2212 x 1659 pixels.
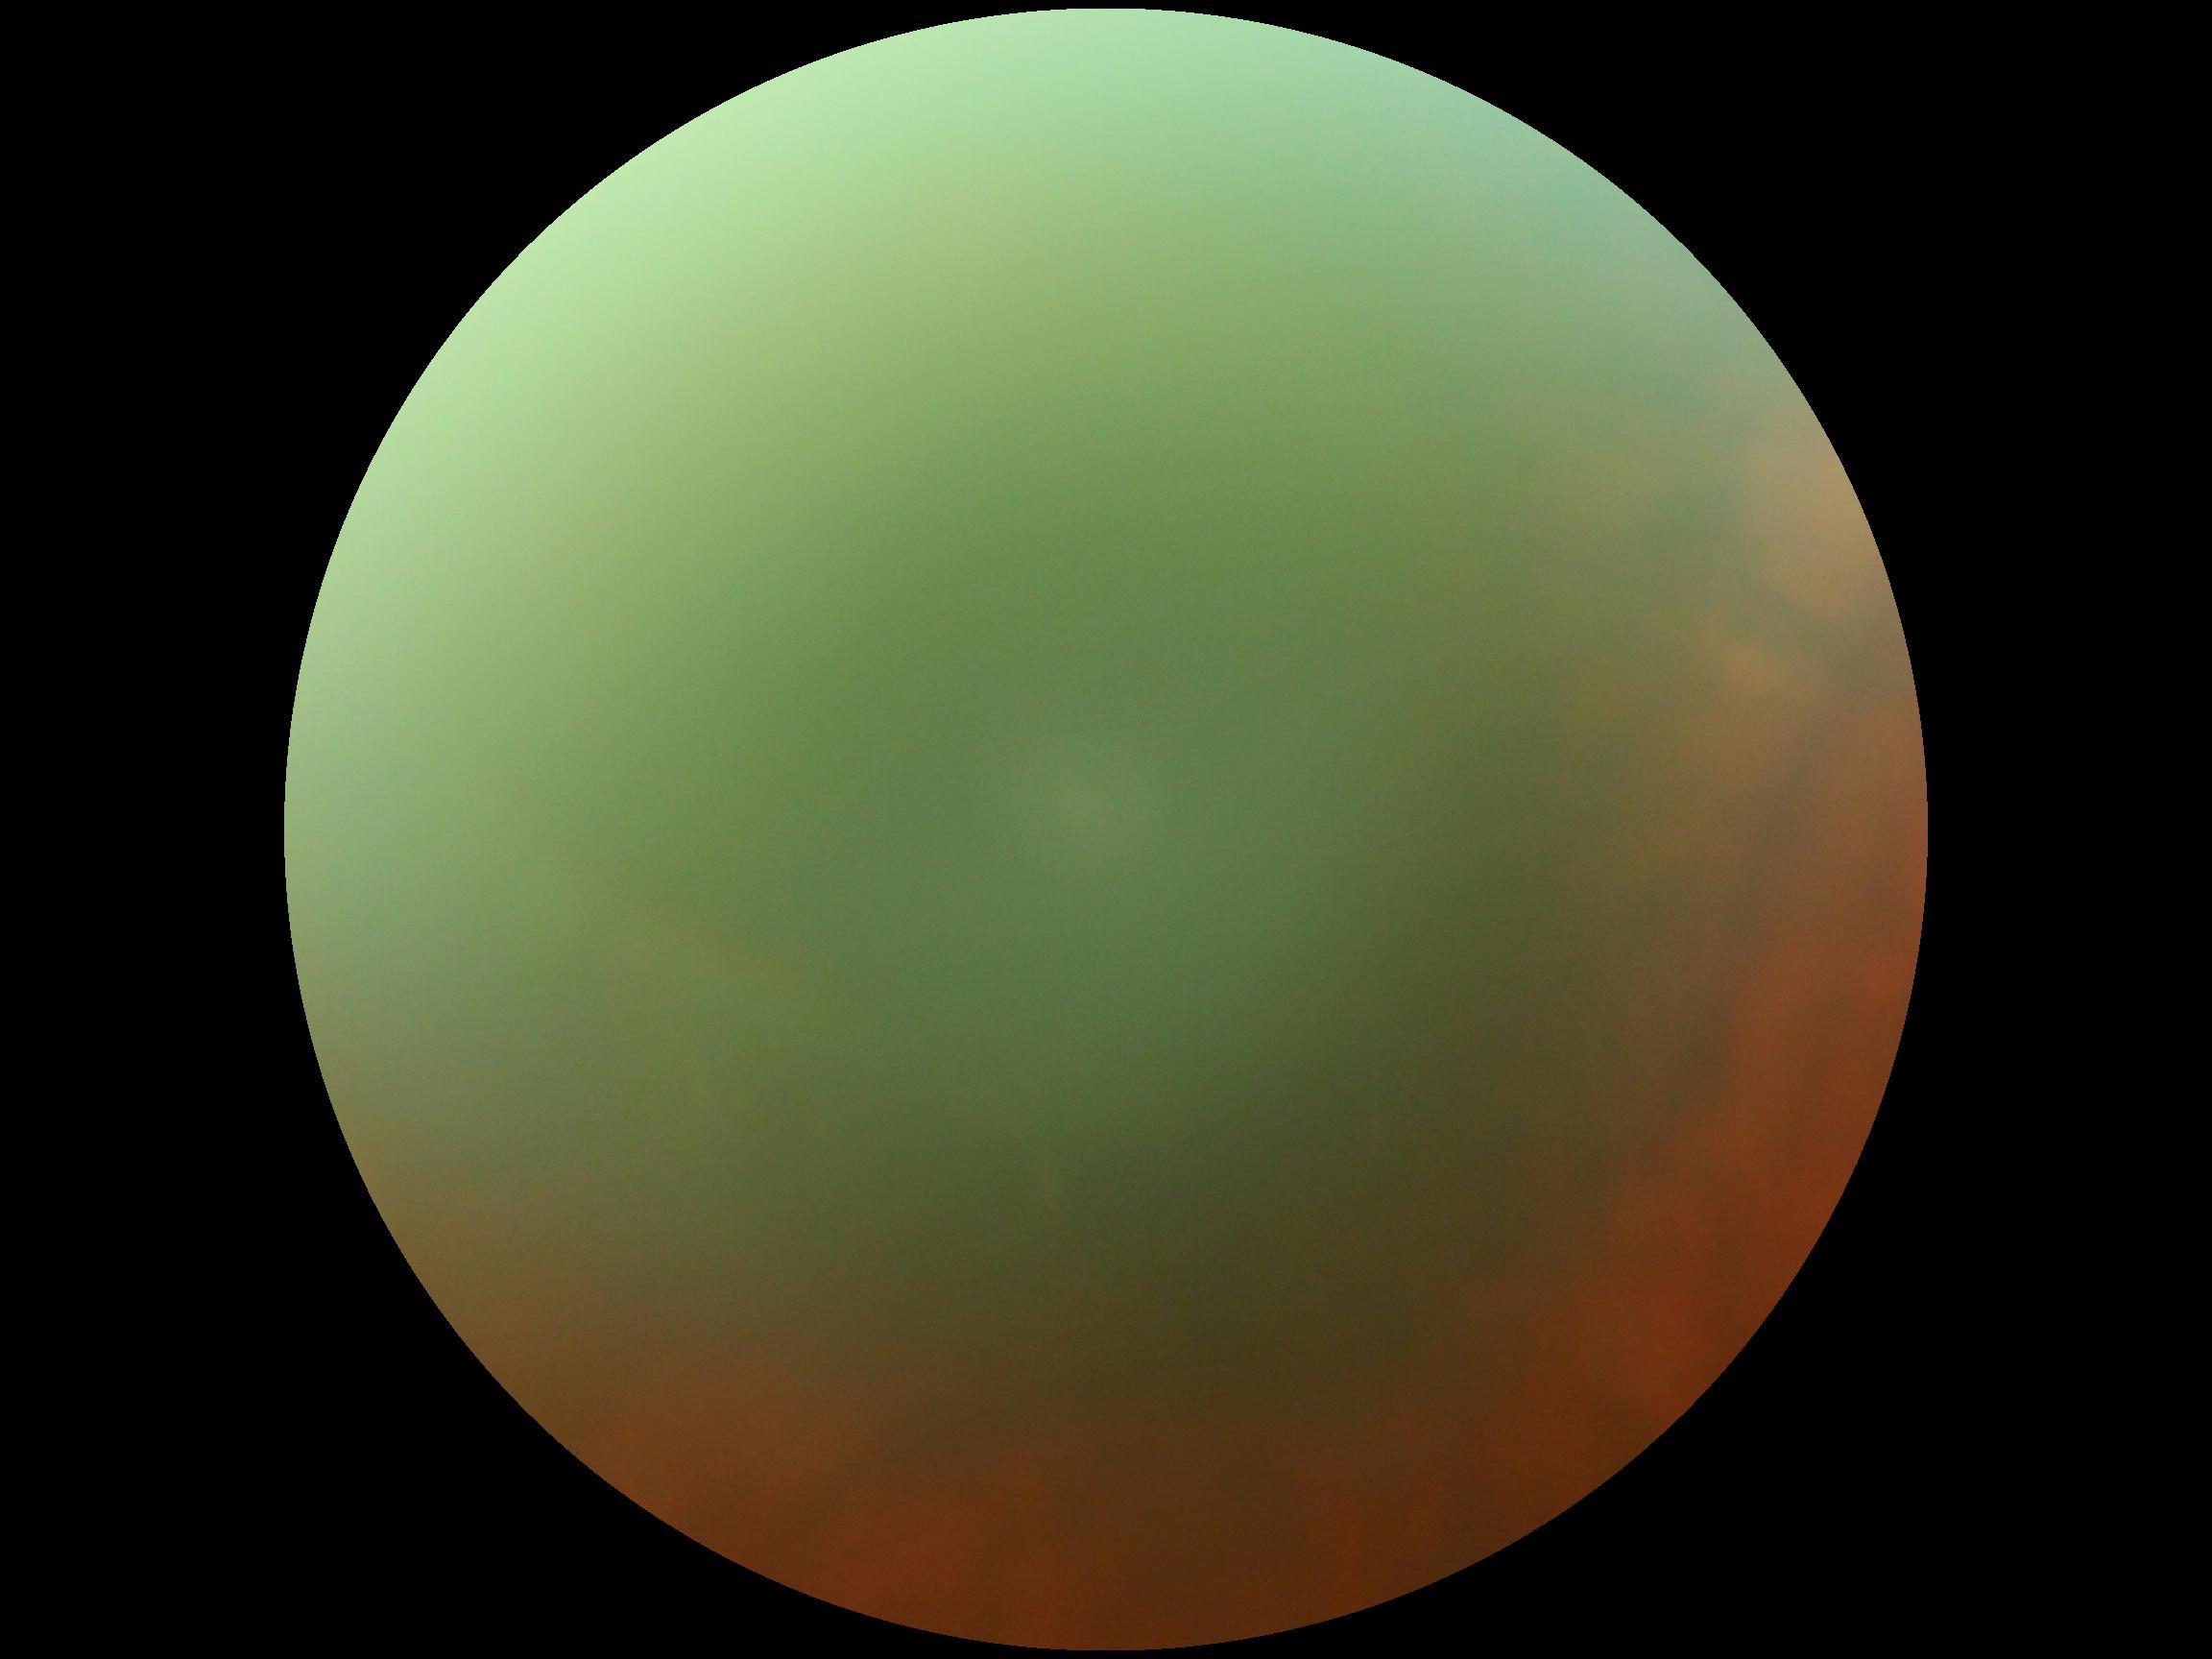
Diabetic retinopathy (DR) is ungradable.